Non-mydriatic acquisition · 240x240
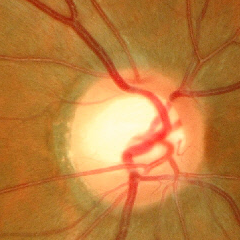
Assessment = no glaucoma.